Pediatric wide-field fundus photograph: 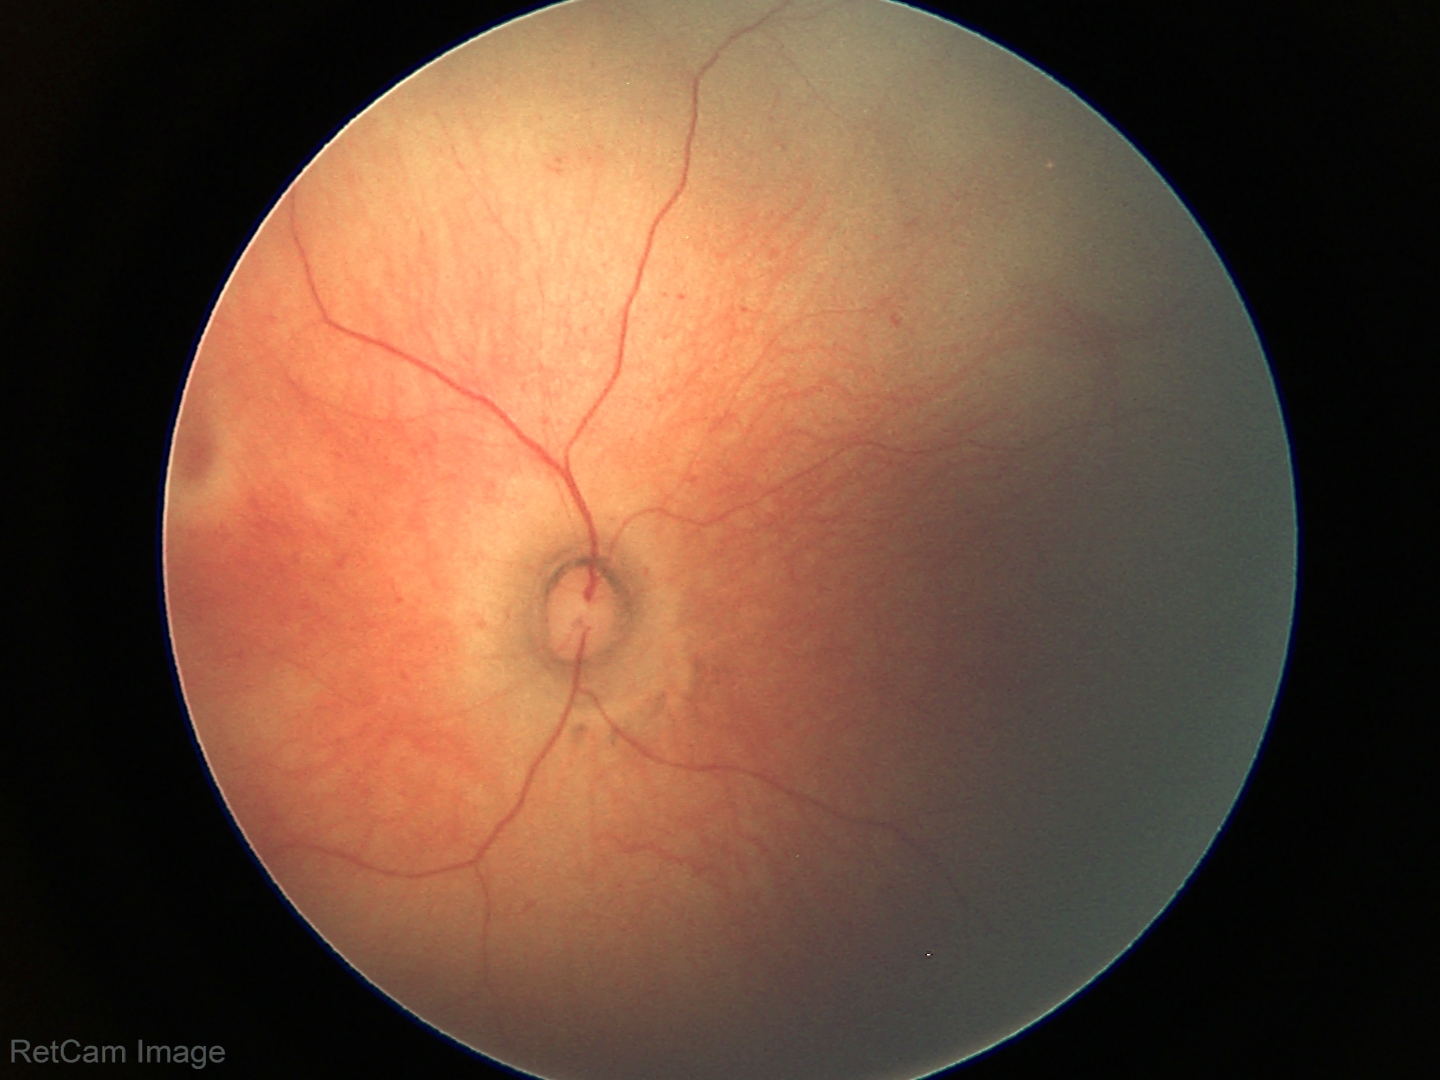 Assessment: no abnormal retinal findings.